Diabetic retinopathy graded by the modified Davis classification; 848 x 848 pixels:
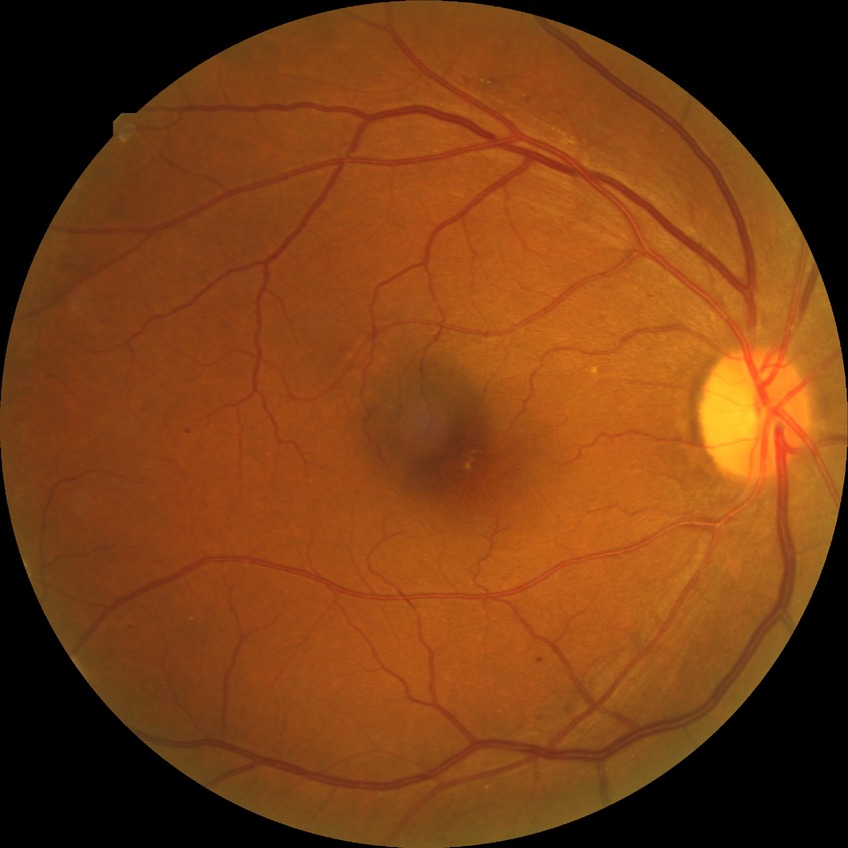
DR class: non-proliferative diabetic retinopathy.
Modified Davis grading: simple diabetic retinopathy.